Non-mydriatic acquisition.
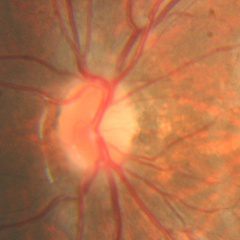
Q: Is glaucoma present?
A: No glaucoma.